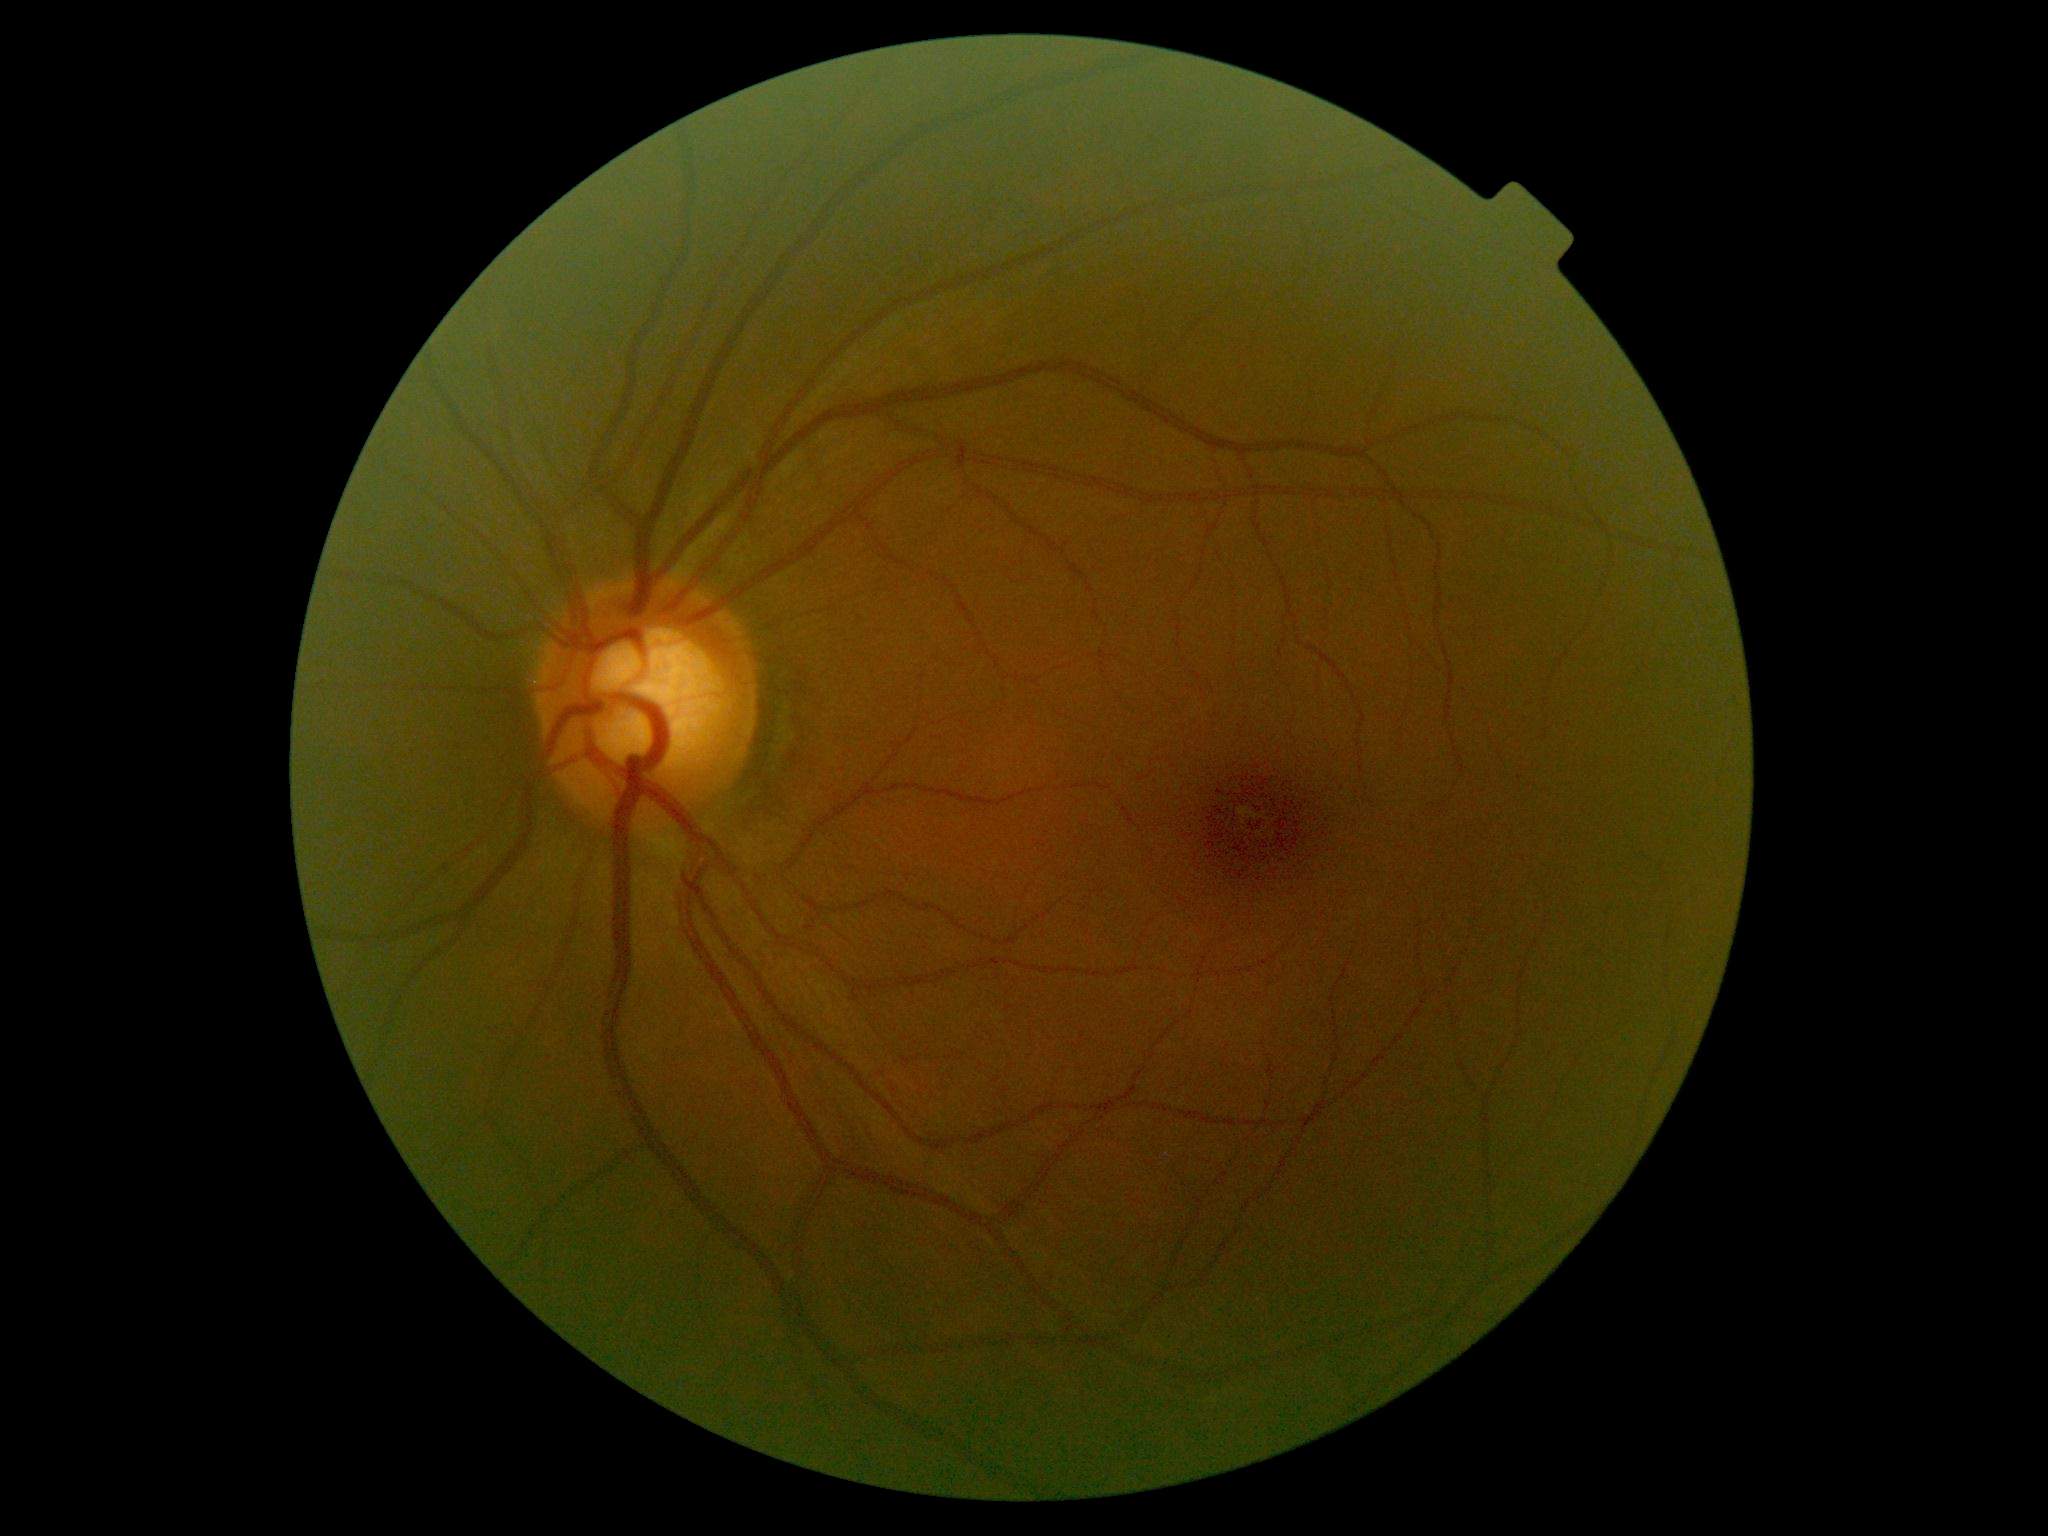 Diabetic retinopathy (DR) is 0/4 — no visible signs of diabetic retinopathy.
No DR findings.